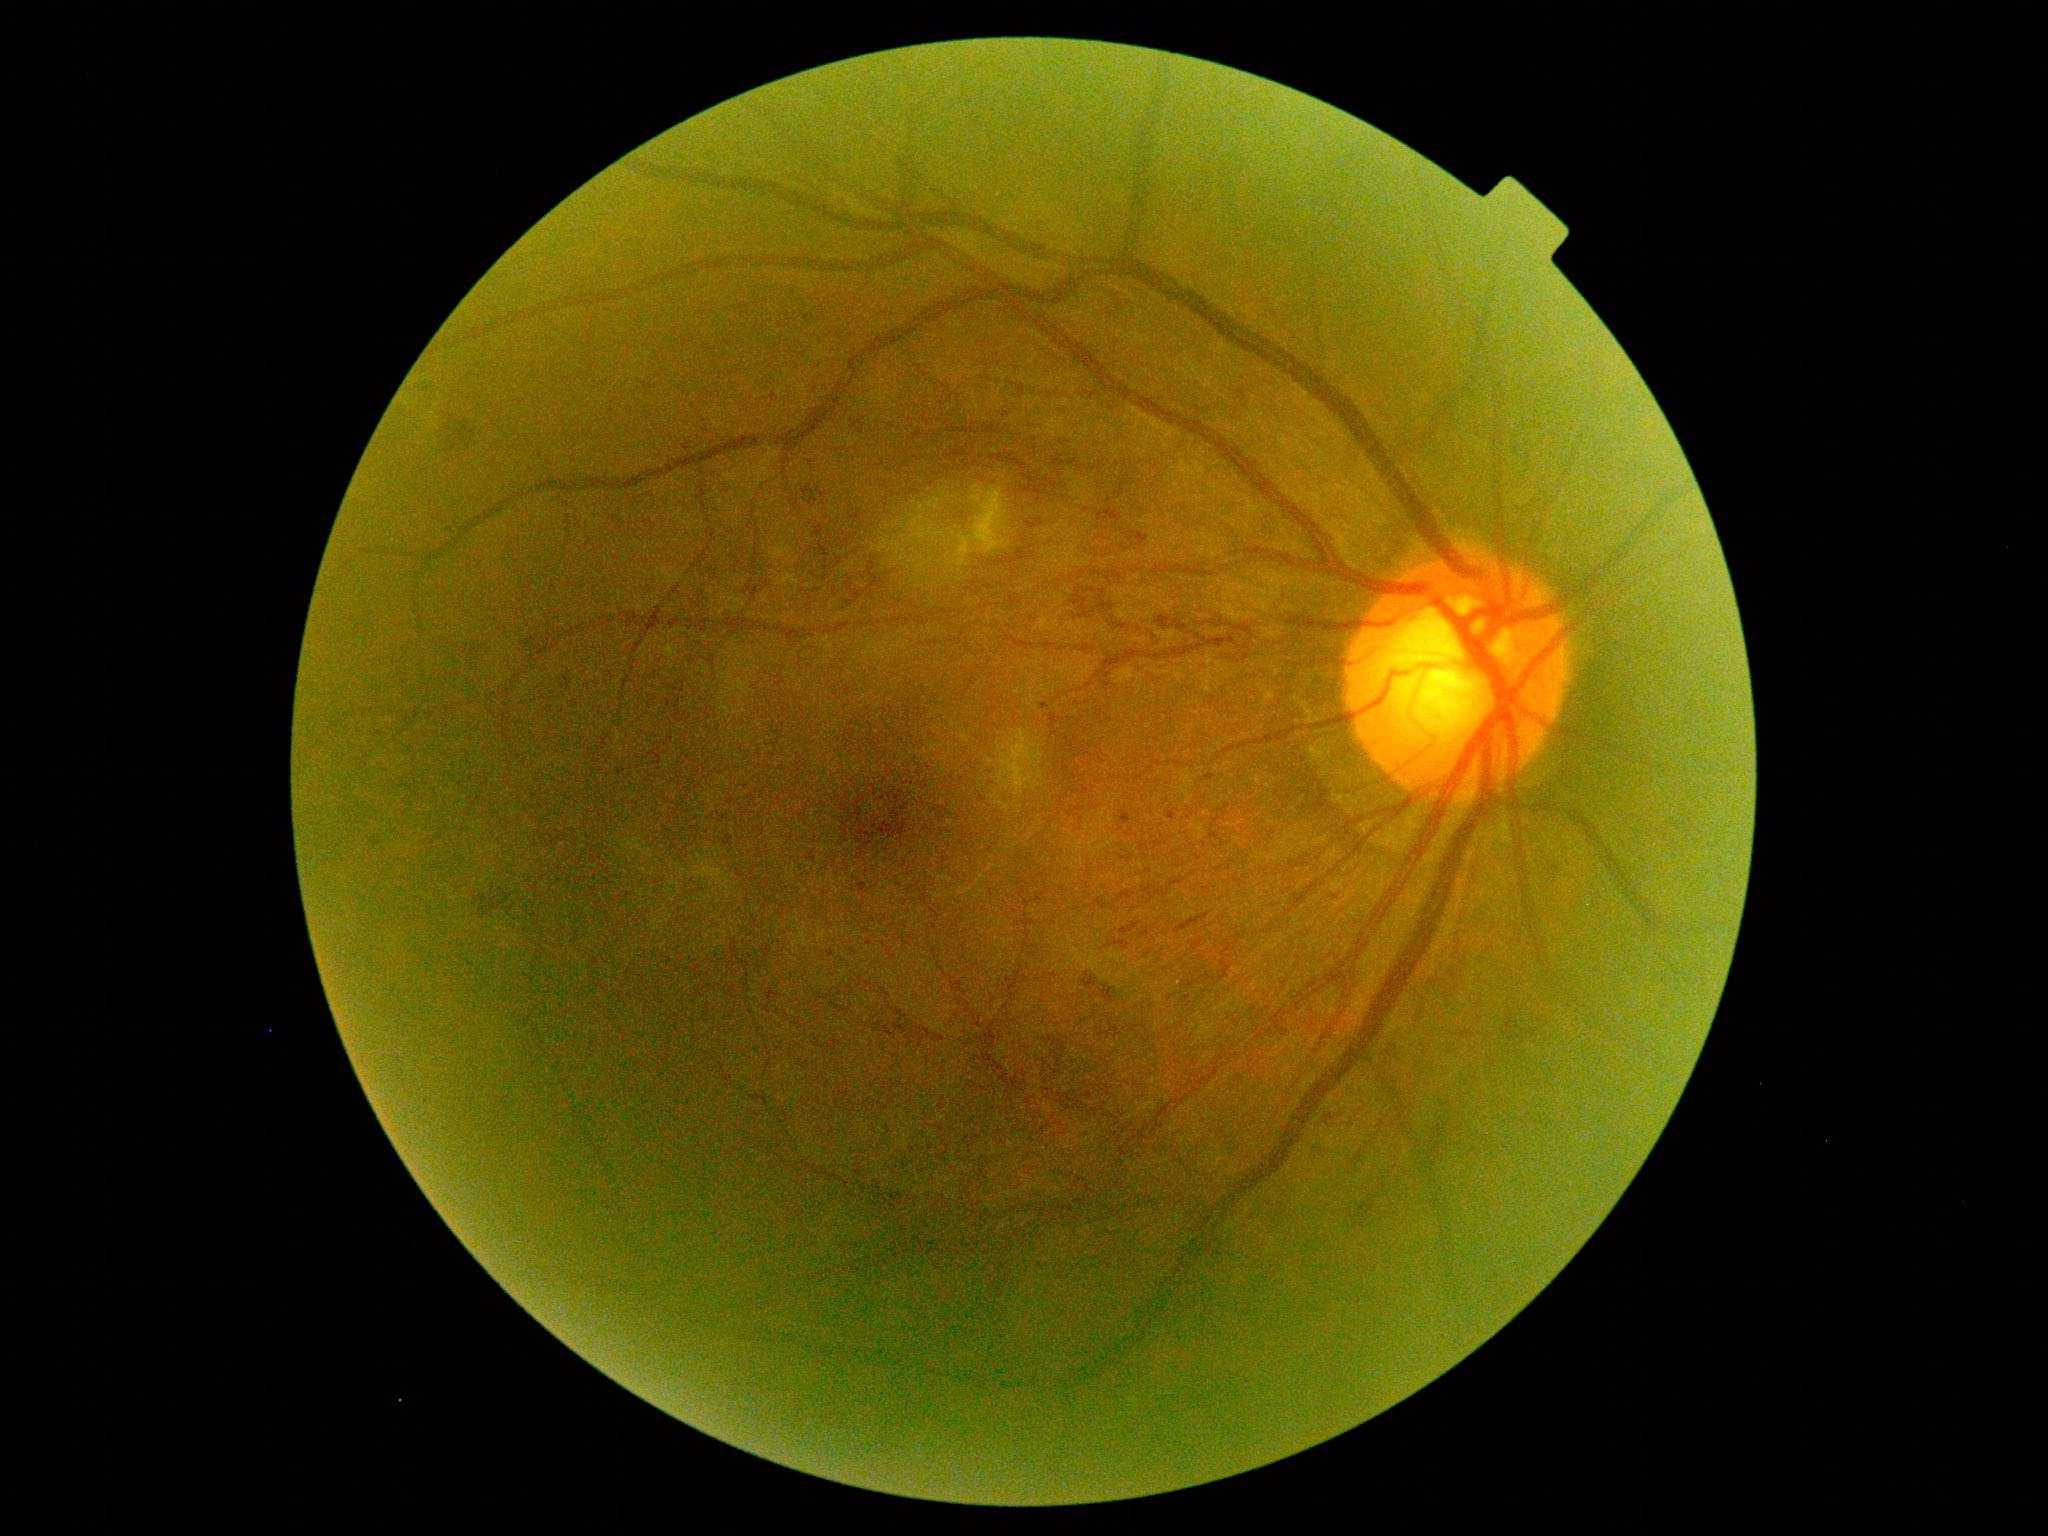

DR grade: 3.